NIDEK AFC-230, 848x848.
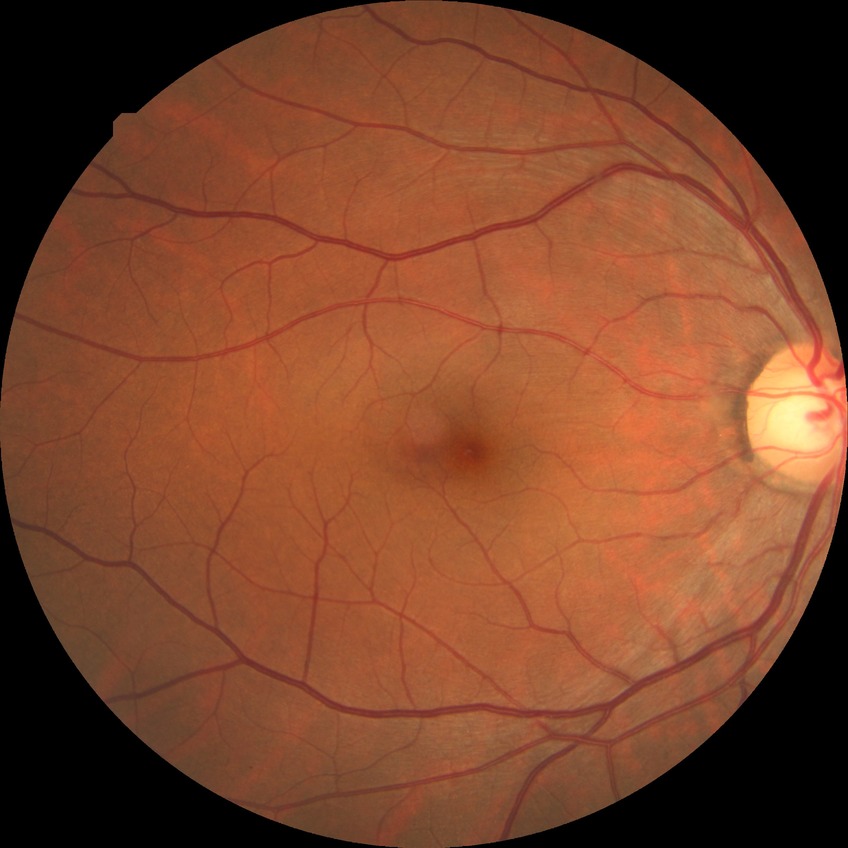

Annotations:
* diabetic retinopathy severity — no diabetic retinopathy